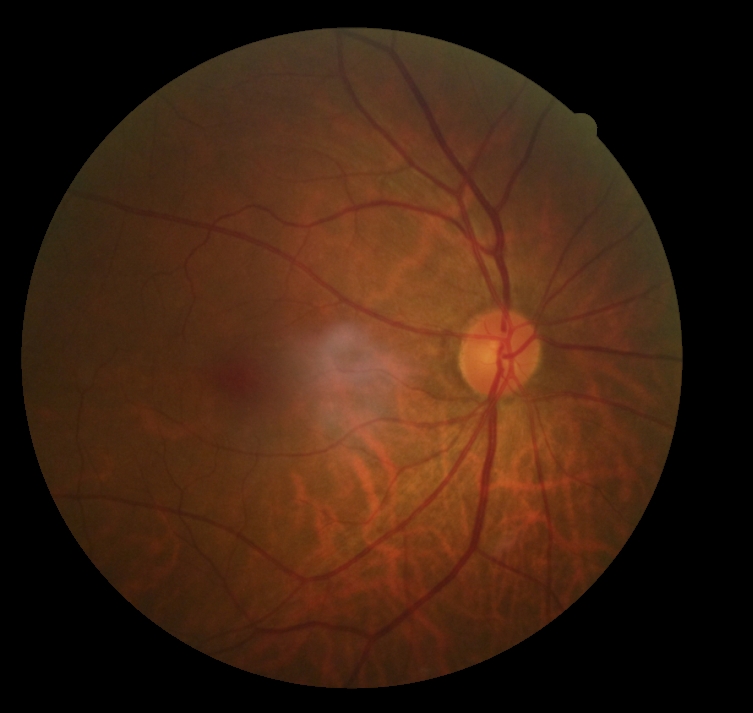
DR severity is 0/4.